Nonmydriatic fundus photograph · FOV: 45 degrees · 848 x 848 pixels · color fundus image · acquired with a NIDEK AFC-230: 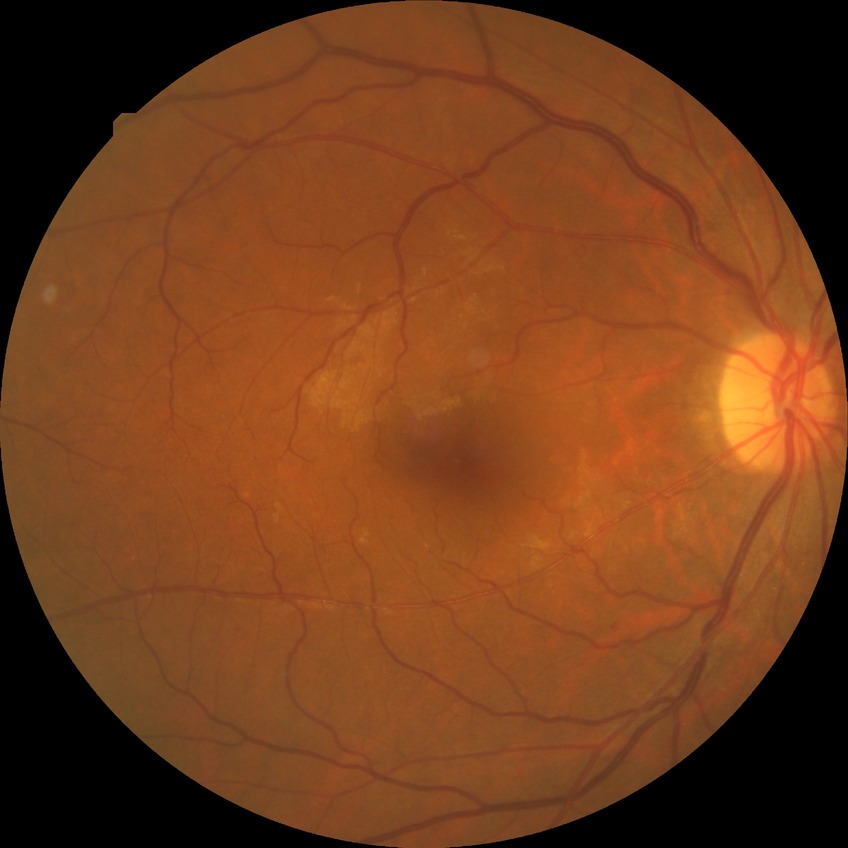

– retinopathy stage: no diabetic retinopathy